CFP: 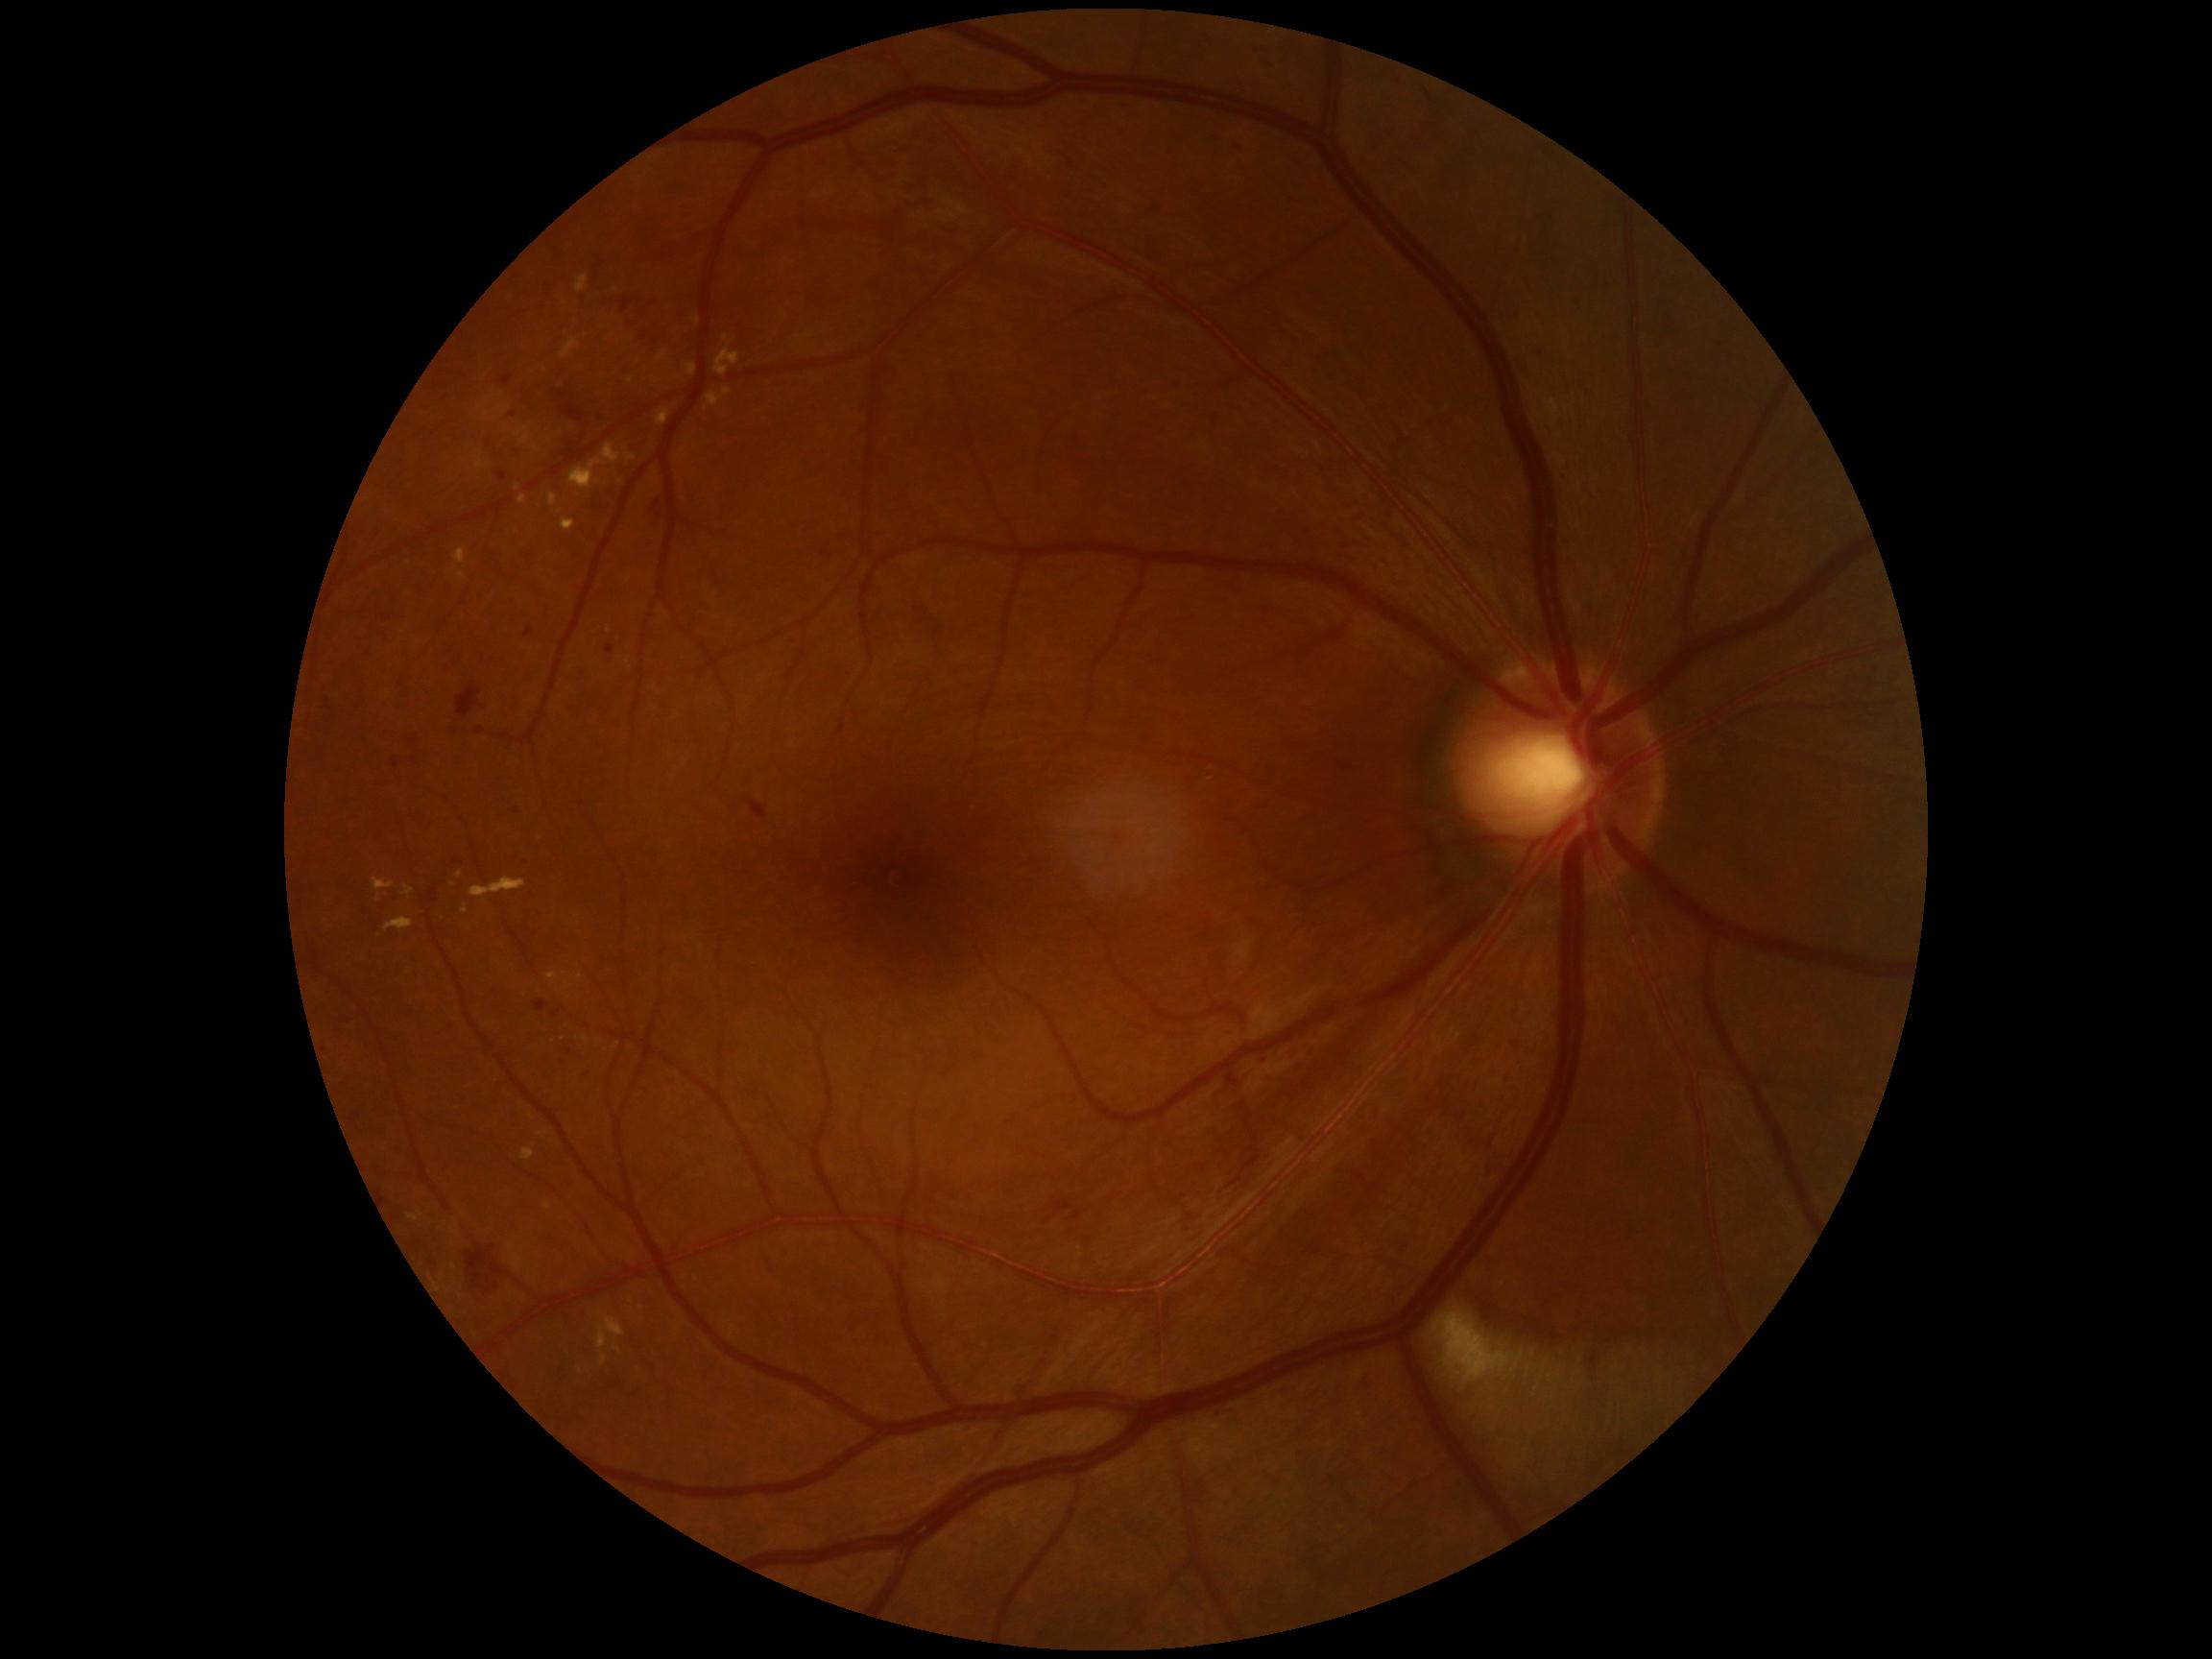

Diabetic retinopathy (DR) is 2/4; non-proliferative diabetic retinopathy.
Hemorrhages (HEs) at 469,1247,505,1300; 748,801,767,820; 457,689,483,718; 565,402,586,423; 648,496,662,524.
Soft exudates (SEs) (partial list) at 1436,1314,1510,1382.
Small SEs near 1522:1356; 1534:1355; 1550:1379.
Microaneurysms (MAs) at 536,1001,547,1013; 558,393,567,400; 498,472,507,481; 391,758,399,768; 607,646,614,655; 500,376,514,386; 524,629,533,638; 1512,1043,1520,1049.
Small MAs near 513:416; 317:967; 655:343.
Hard exudates (EXs) (partial list) at 517,428,529,444; 548,493,558,507; 714,348,739,376; 656,410,670,426; 459,572,467,579; 660,350,667,360; 373,878,395,892; 409,1214,423,1221; 569,444,621,491; 565,982,571,992.
Small EXs near 460:876; 505:411; 462:1296; 632:1303; 630:381; 629:663; 536:447.